45° field of view · retinal fundus photograph — 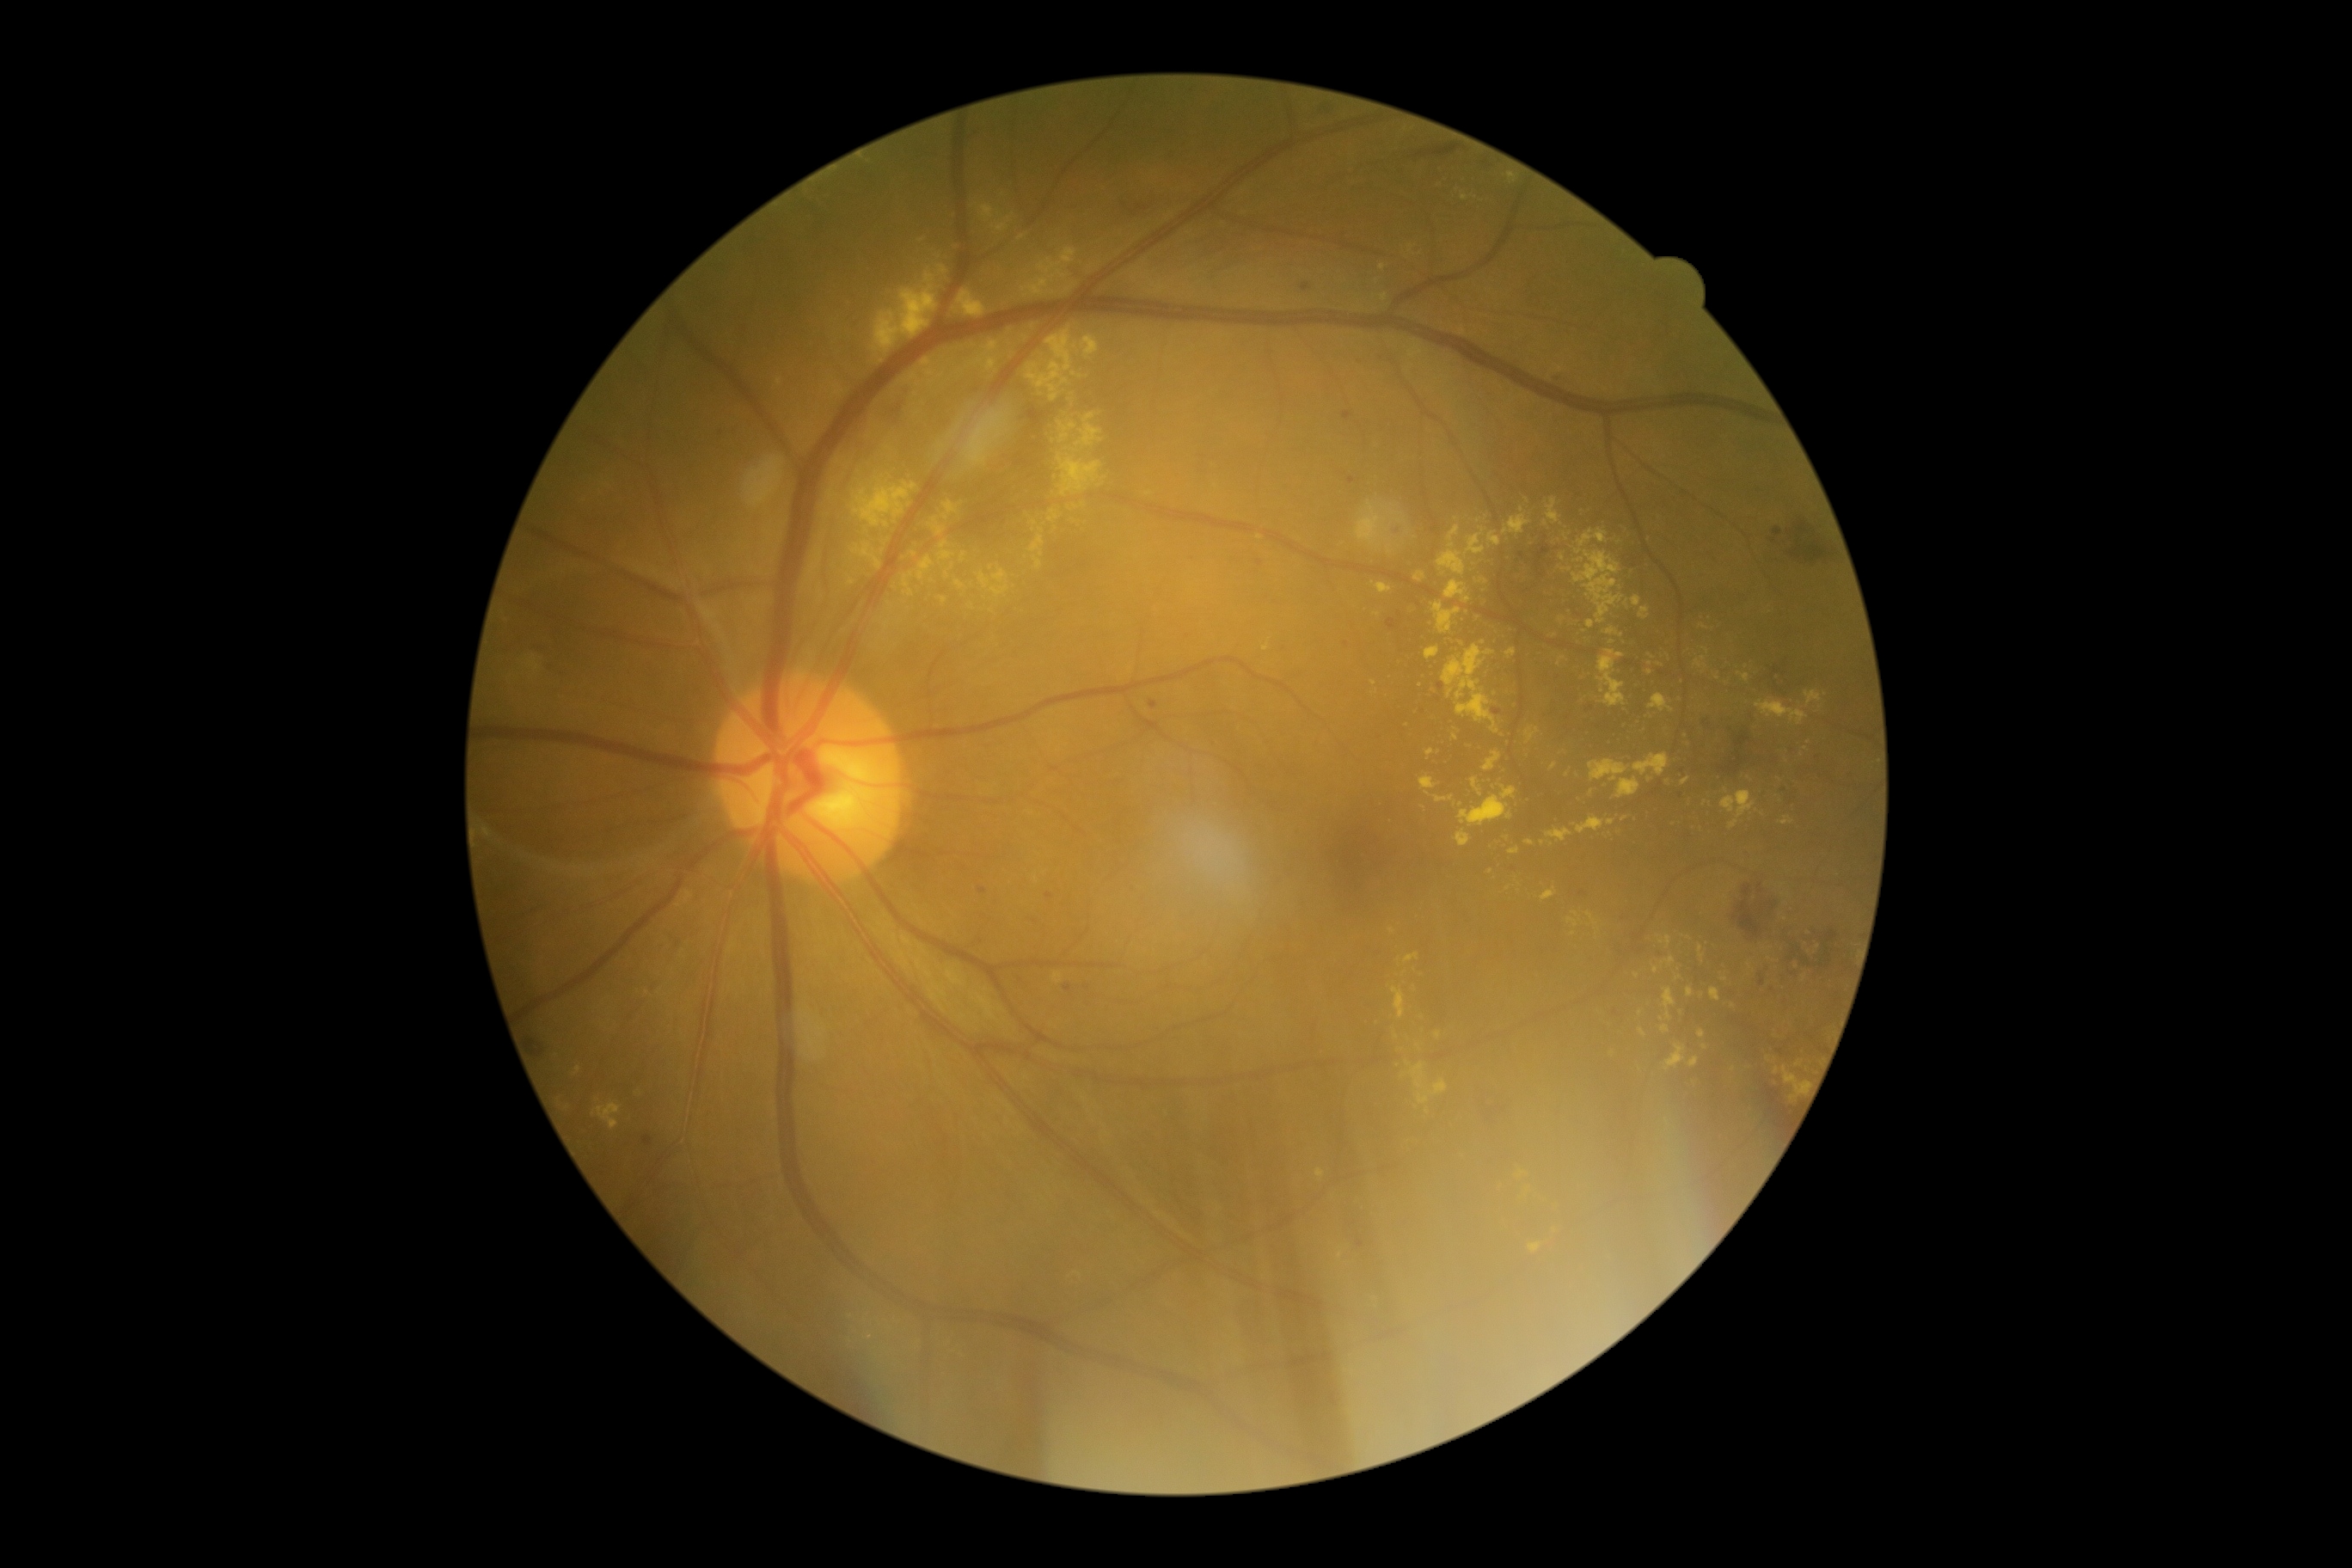

<lesions partial="true">
  <dr_grade>2</dr_grade>
  <ex partial="true">box=[1478, 579, 1488, 585]; box=[981, 205, 995, 221]; box=[1639, 608, 1651, 620]; box=[965, 412, 1008, 469]; box=[1445, 580, 1471, 604]; box=[1660, 1026, 1670, 1034]; box=[1500, 785, 1517, 800]; box=[1075, 413, 1103, 448]; box=[938, 541, 957, 561]; box=[1567, 917, 1579, 928]</ex>
  <ex_small_approx>1491:872; 1707:650; 1084:504; 1785:919; 1703:626; 1076:508; 1592:793; 779:382; 1260:538; 1395:513</ex_small_approx>
</lesions>